1240x1240. Wide-field contact fundus photograph of an infant.
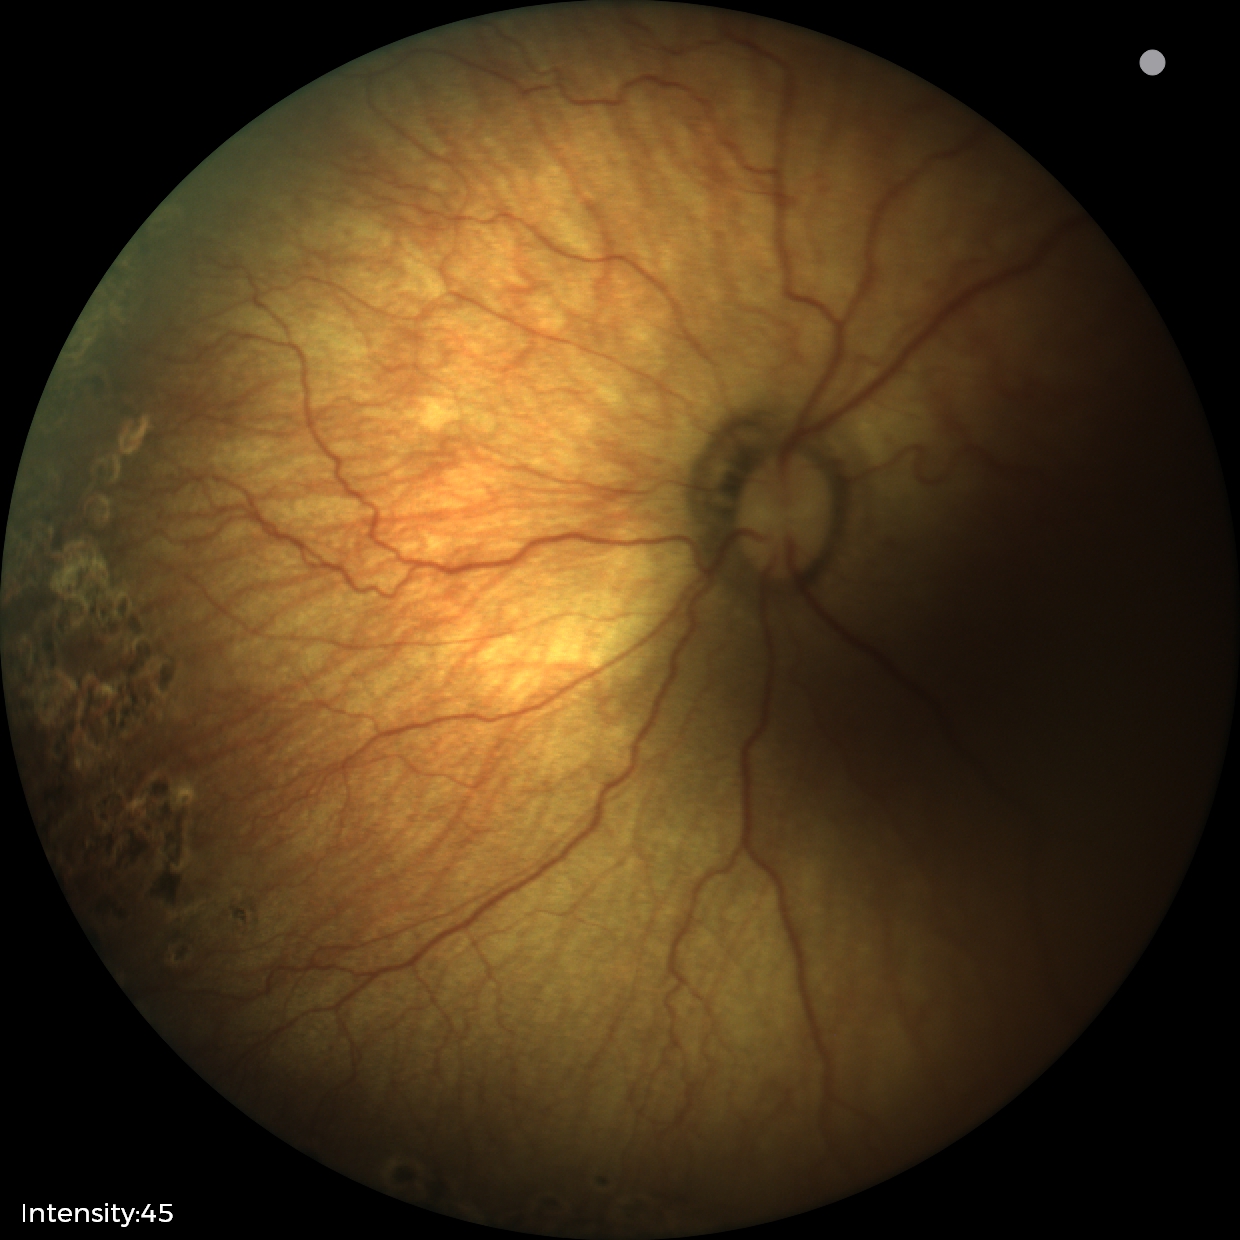 Screening series with status post retinopathy of prematurity (ROP).